2102 by 1736 pixels.
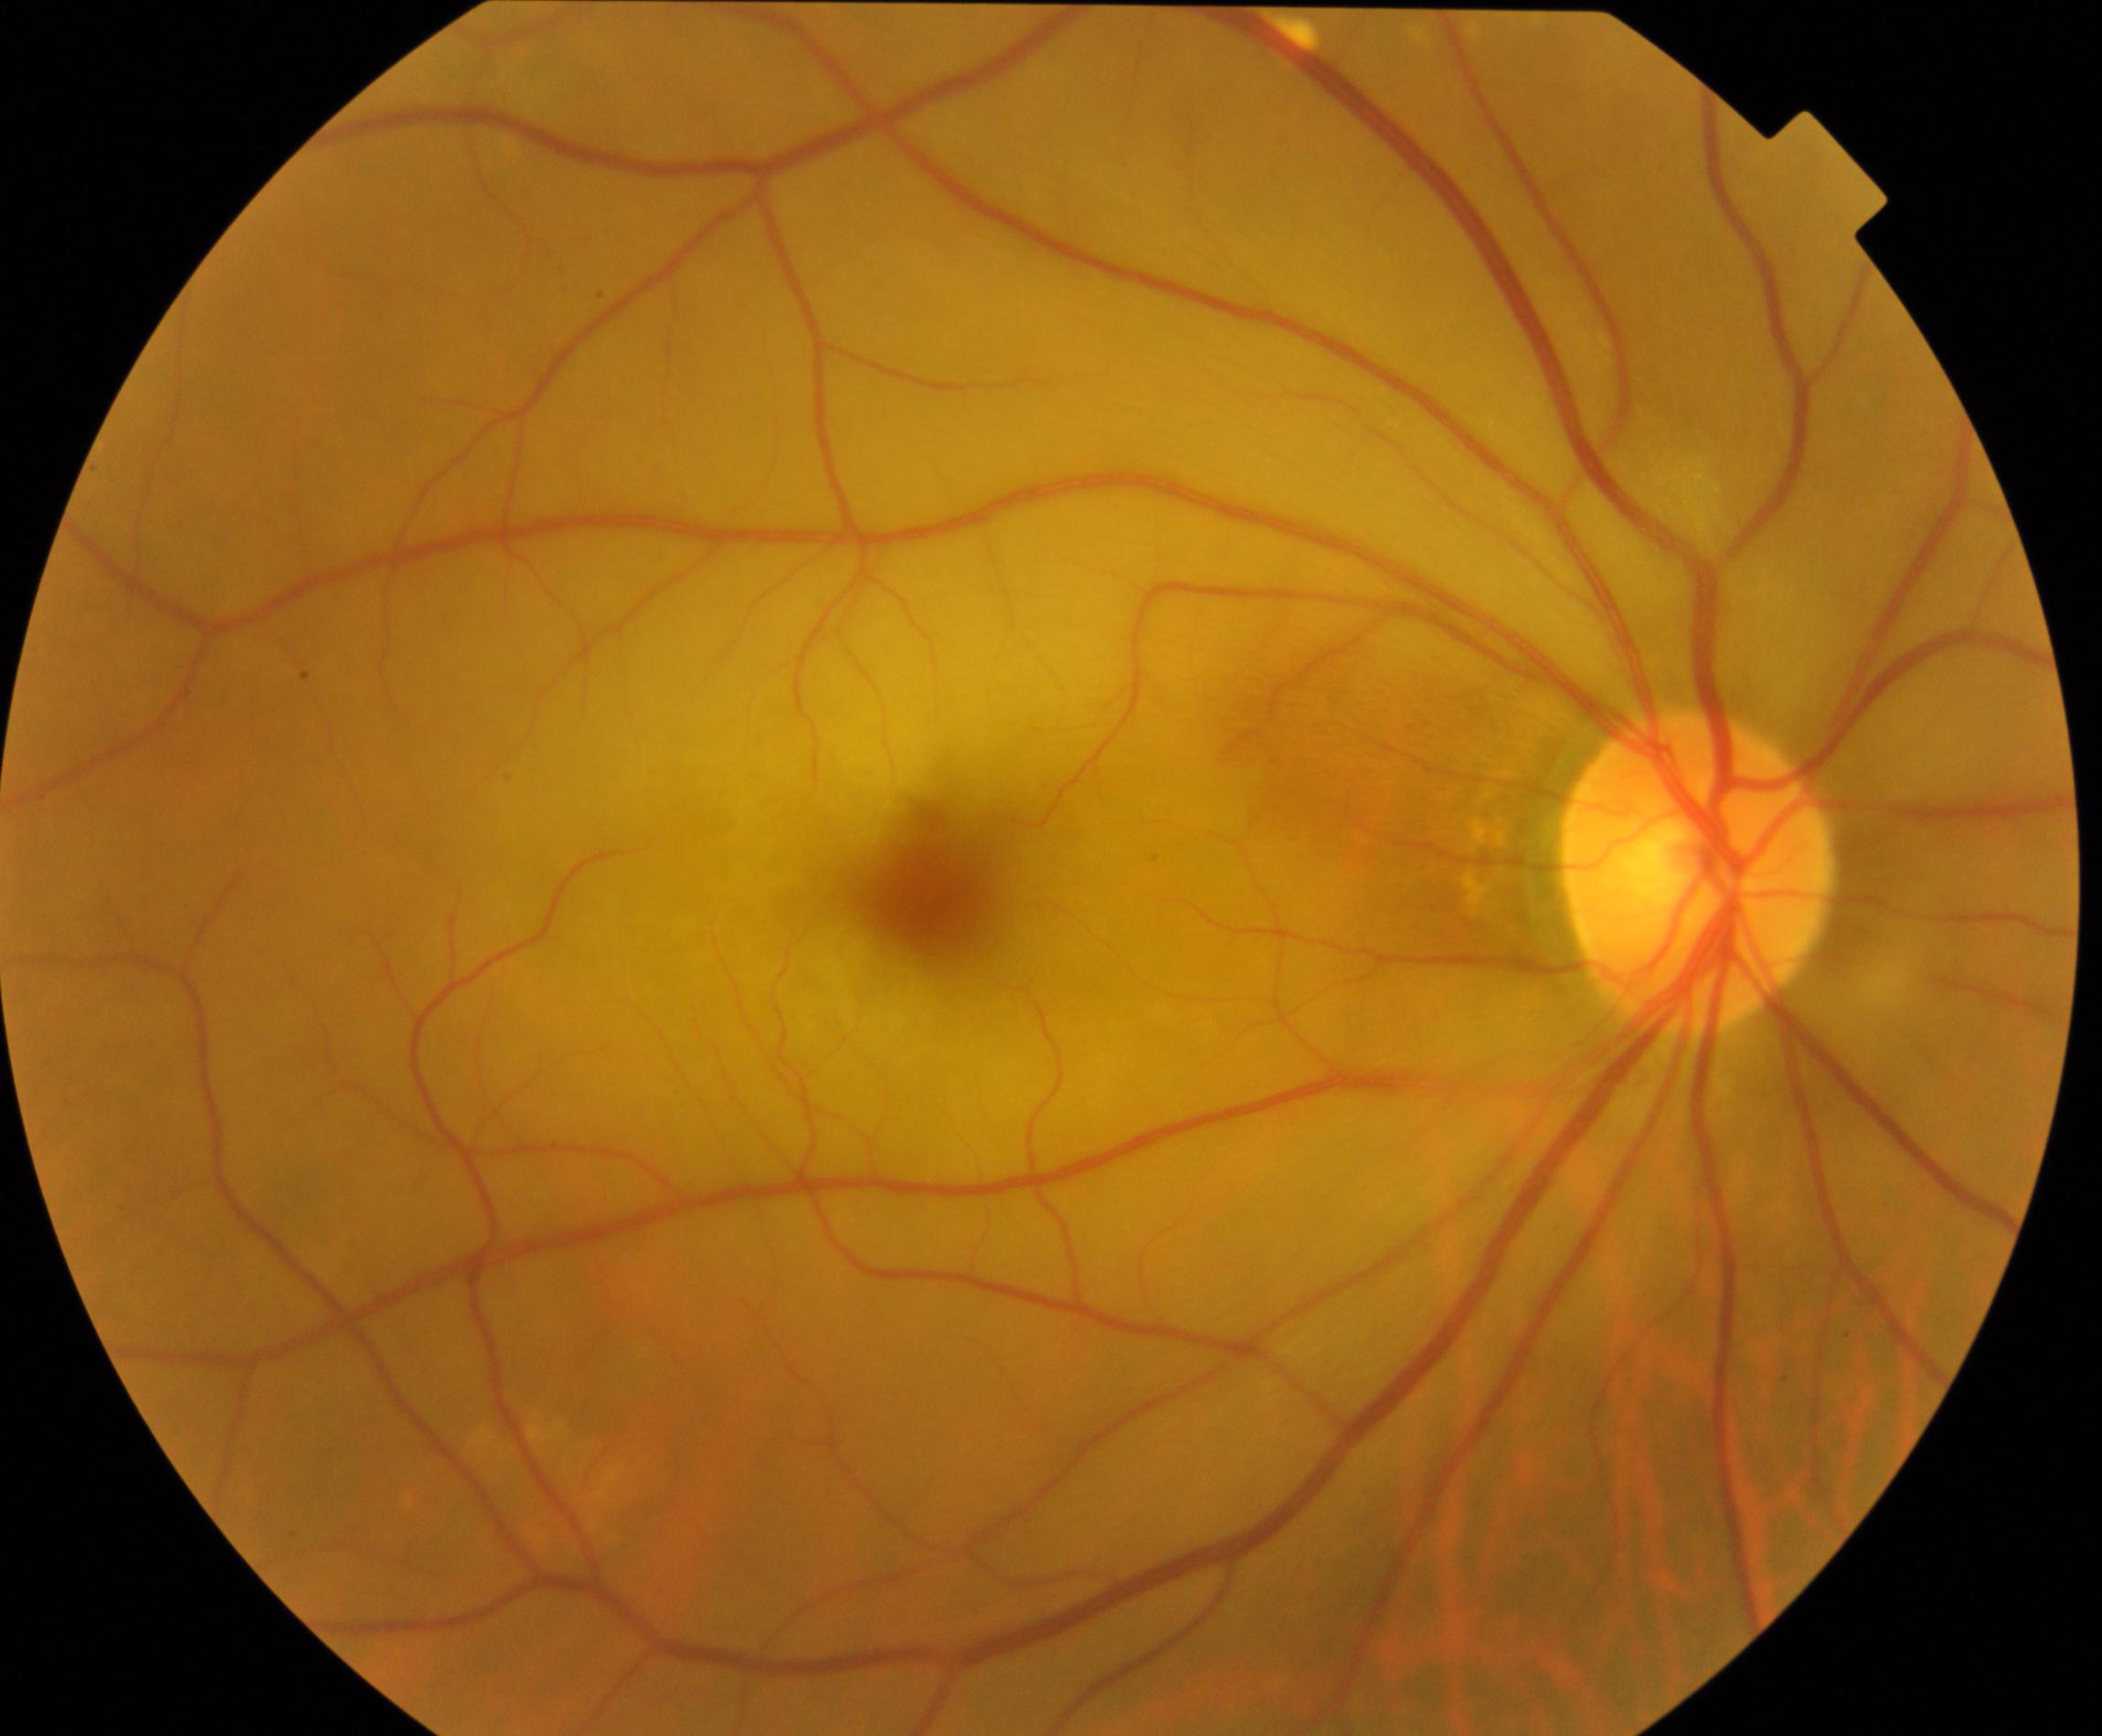

Diagnosis: retinal artery occlusion.